Wide-field fundus photograph from neonatal ROP screening; captured with the Phoenix ICON (100° field of view); image size 1240x1240 — 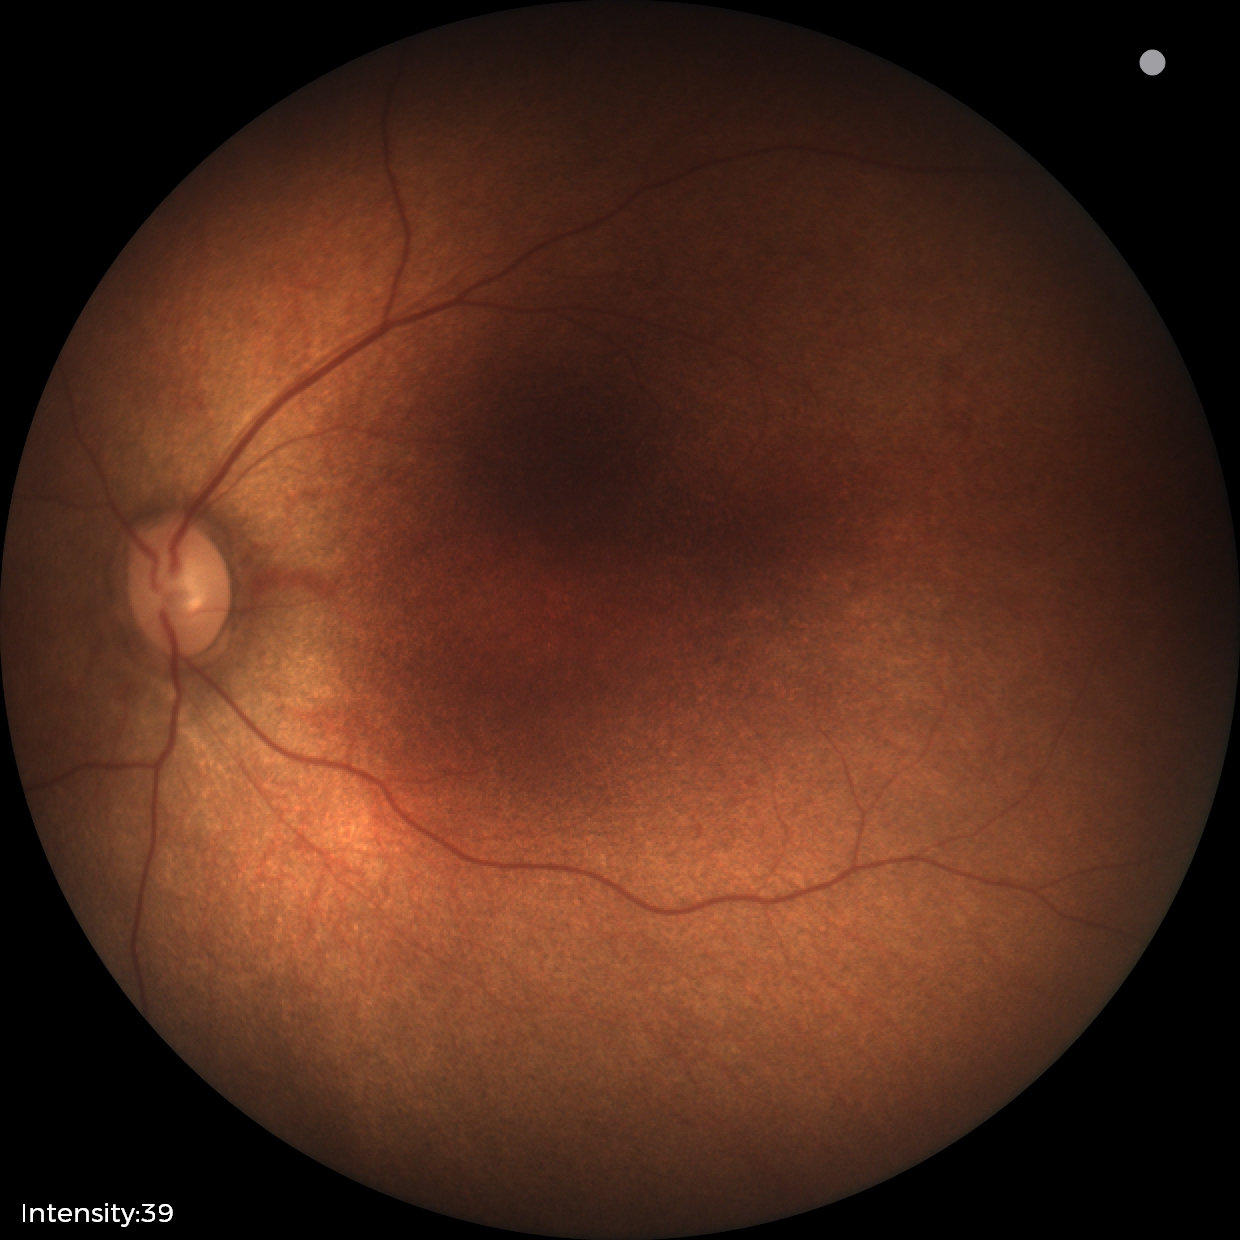

Impression: physiological appearance with no retinal pathology.